Camera: NIDEK AFC-230, color fundus photograph, nonmydriatic fundus photograph
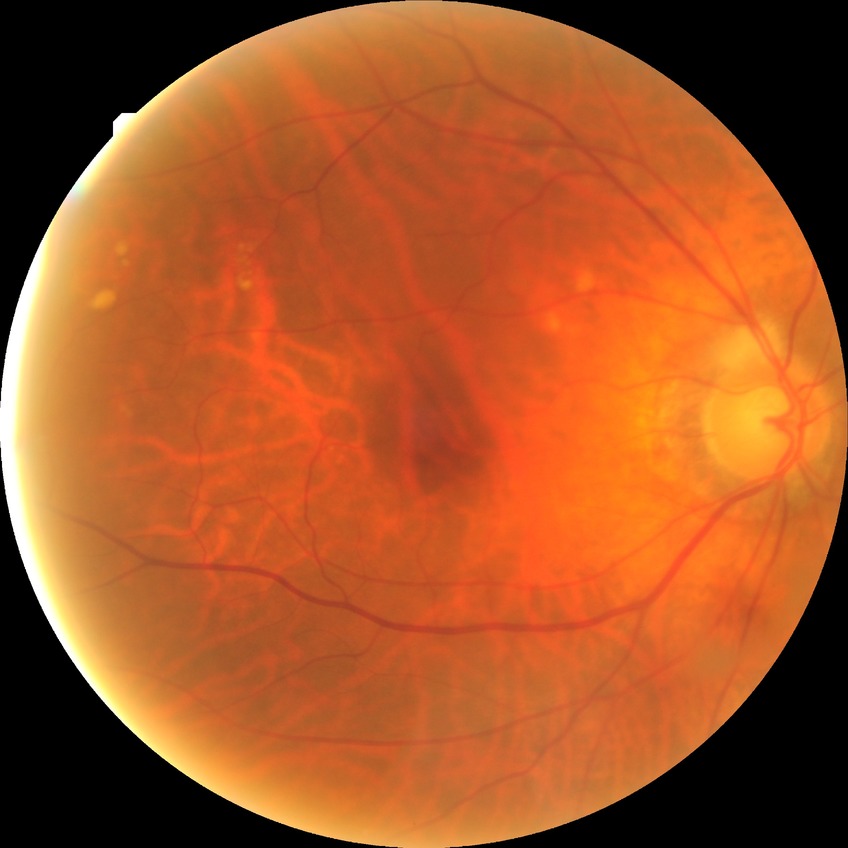

Davis grading: no diabetic retinopathy.